45-degree field of view · 2352 x 1568 pixels.
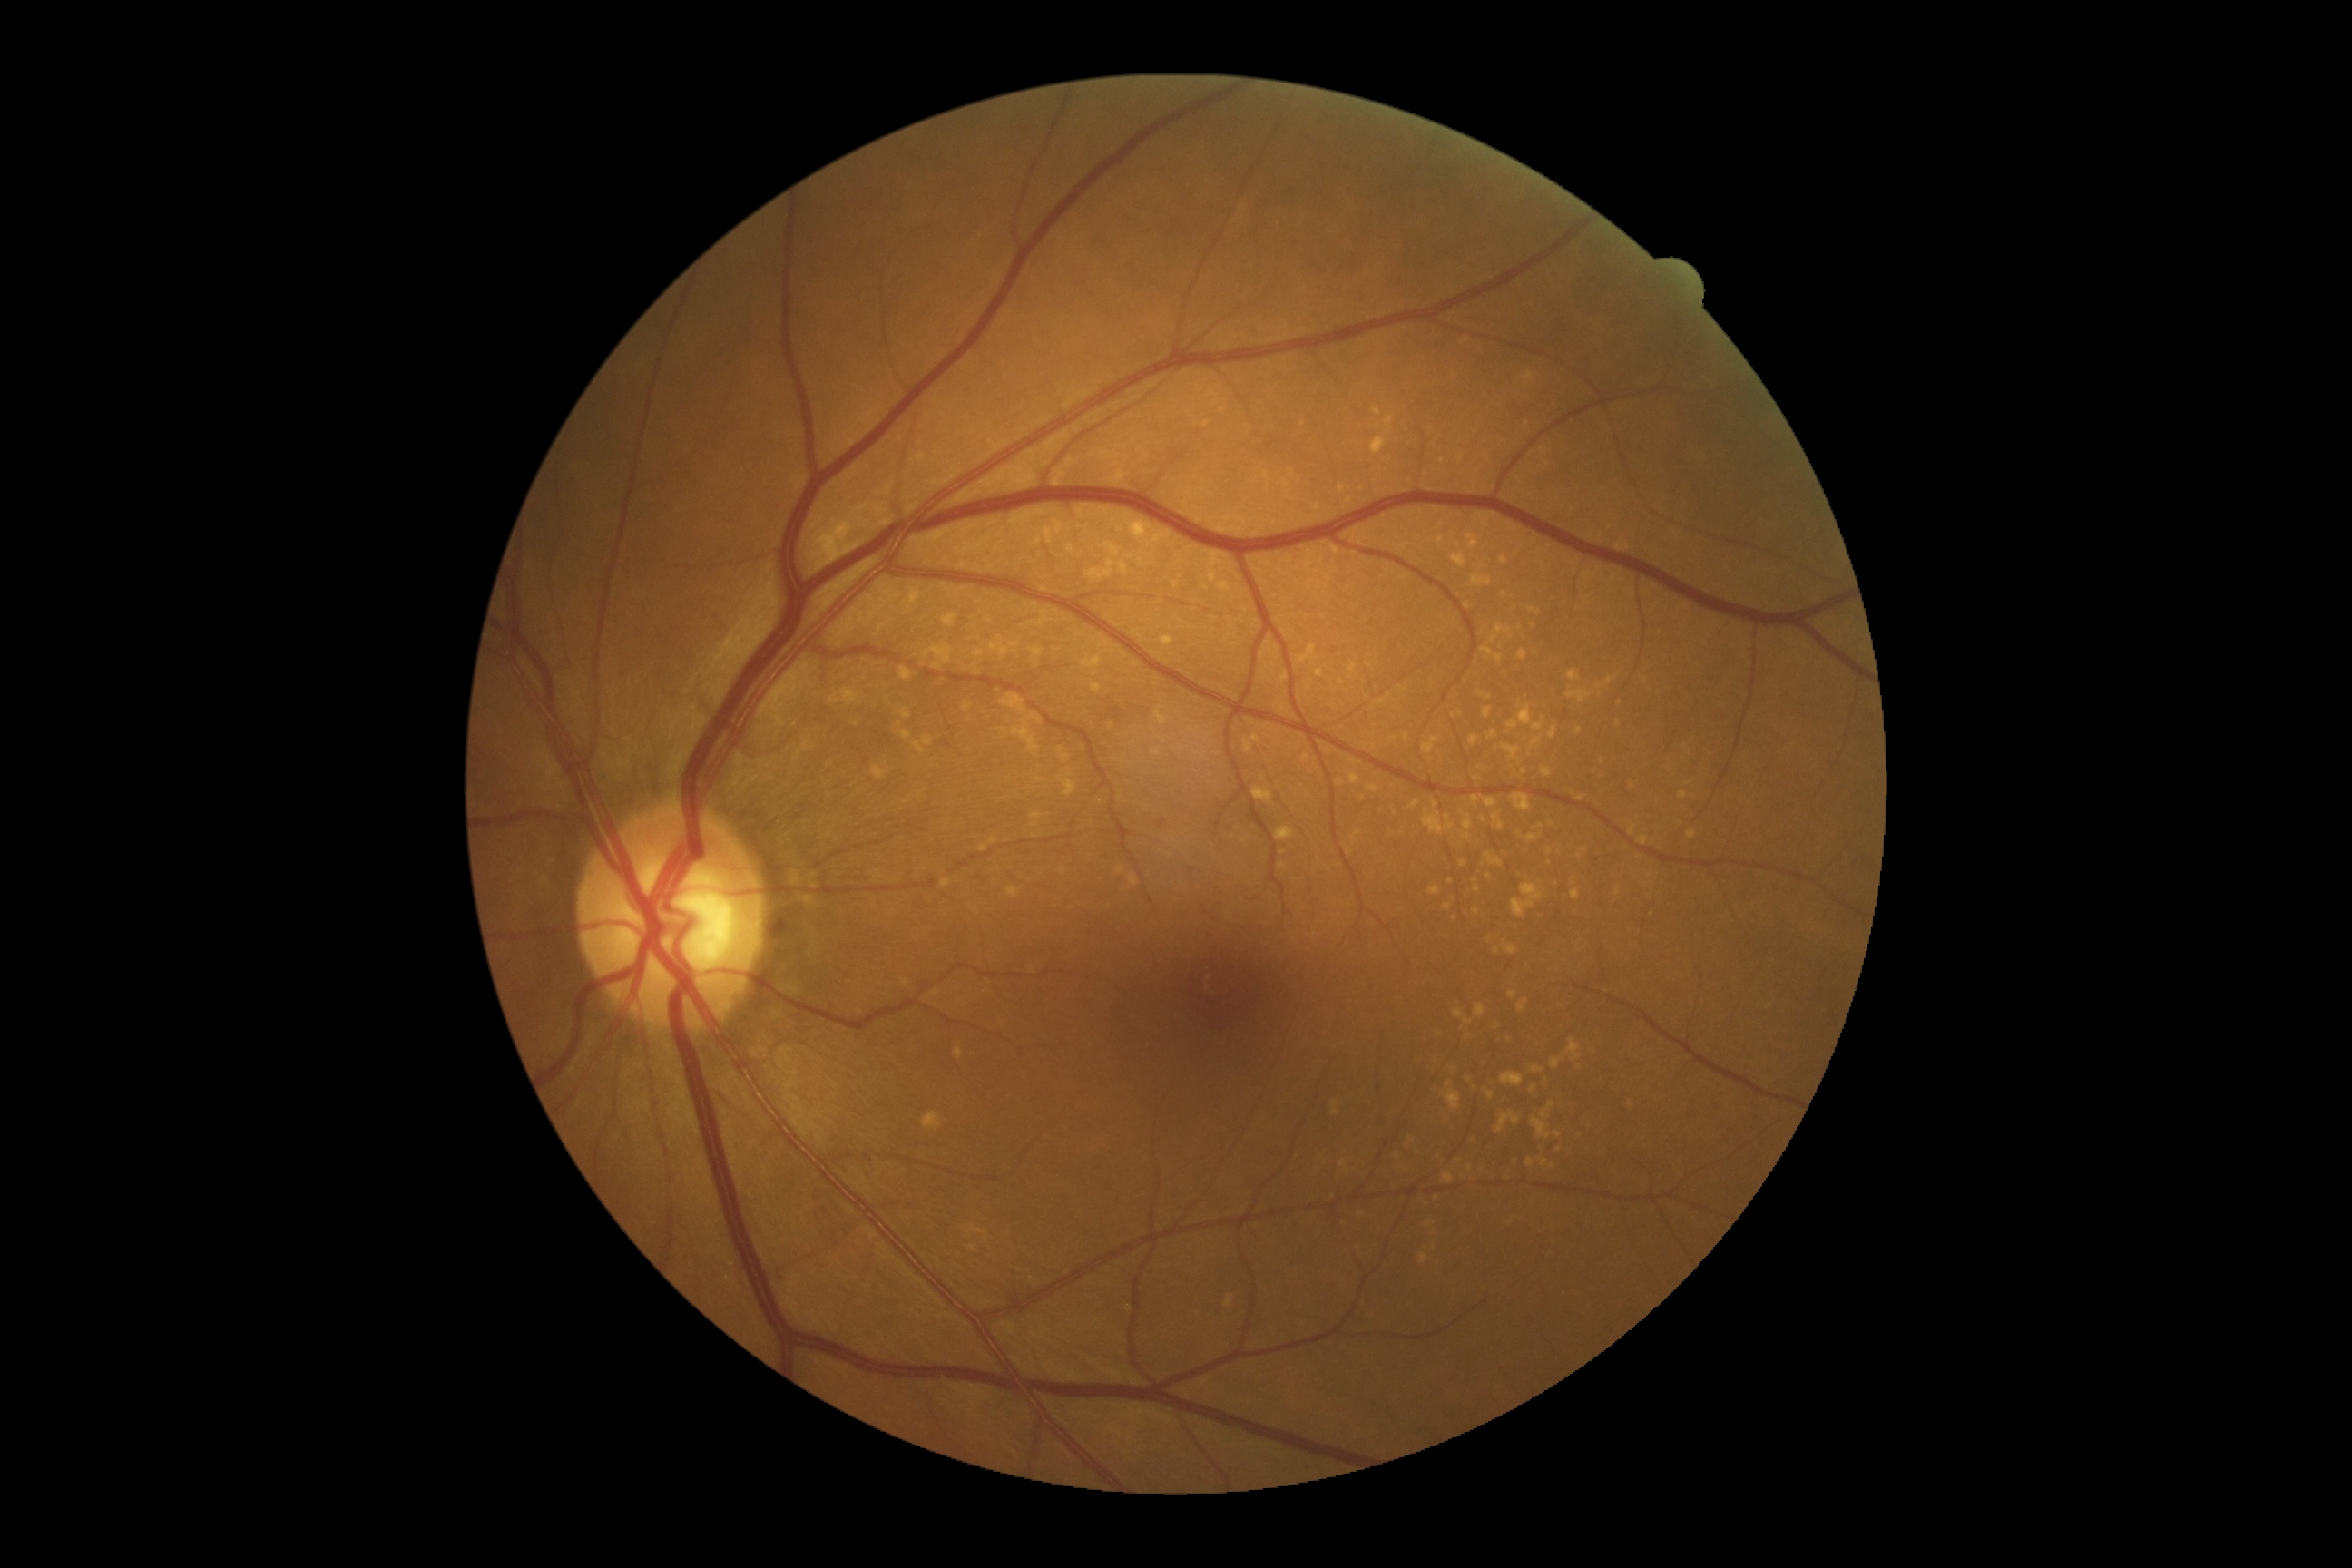

DR is grade 0.